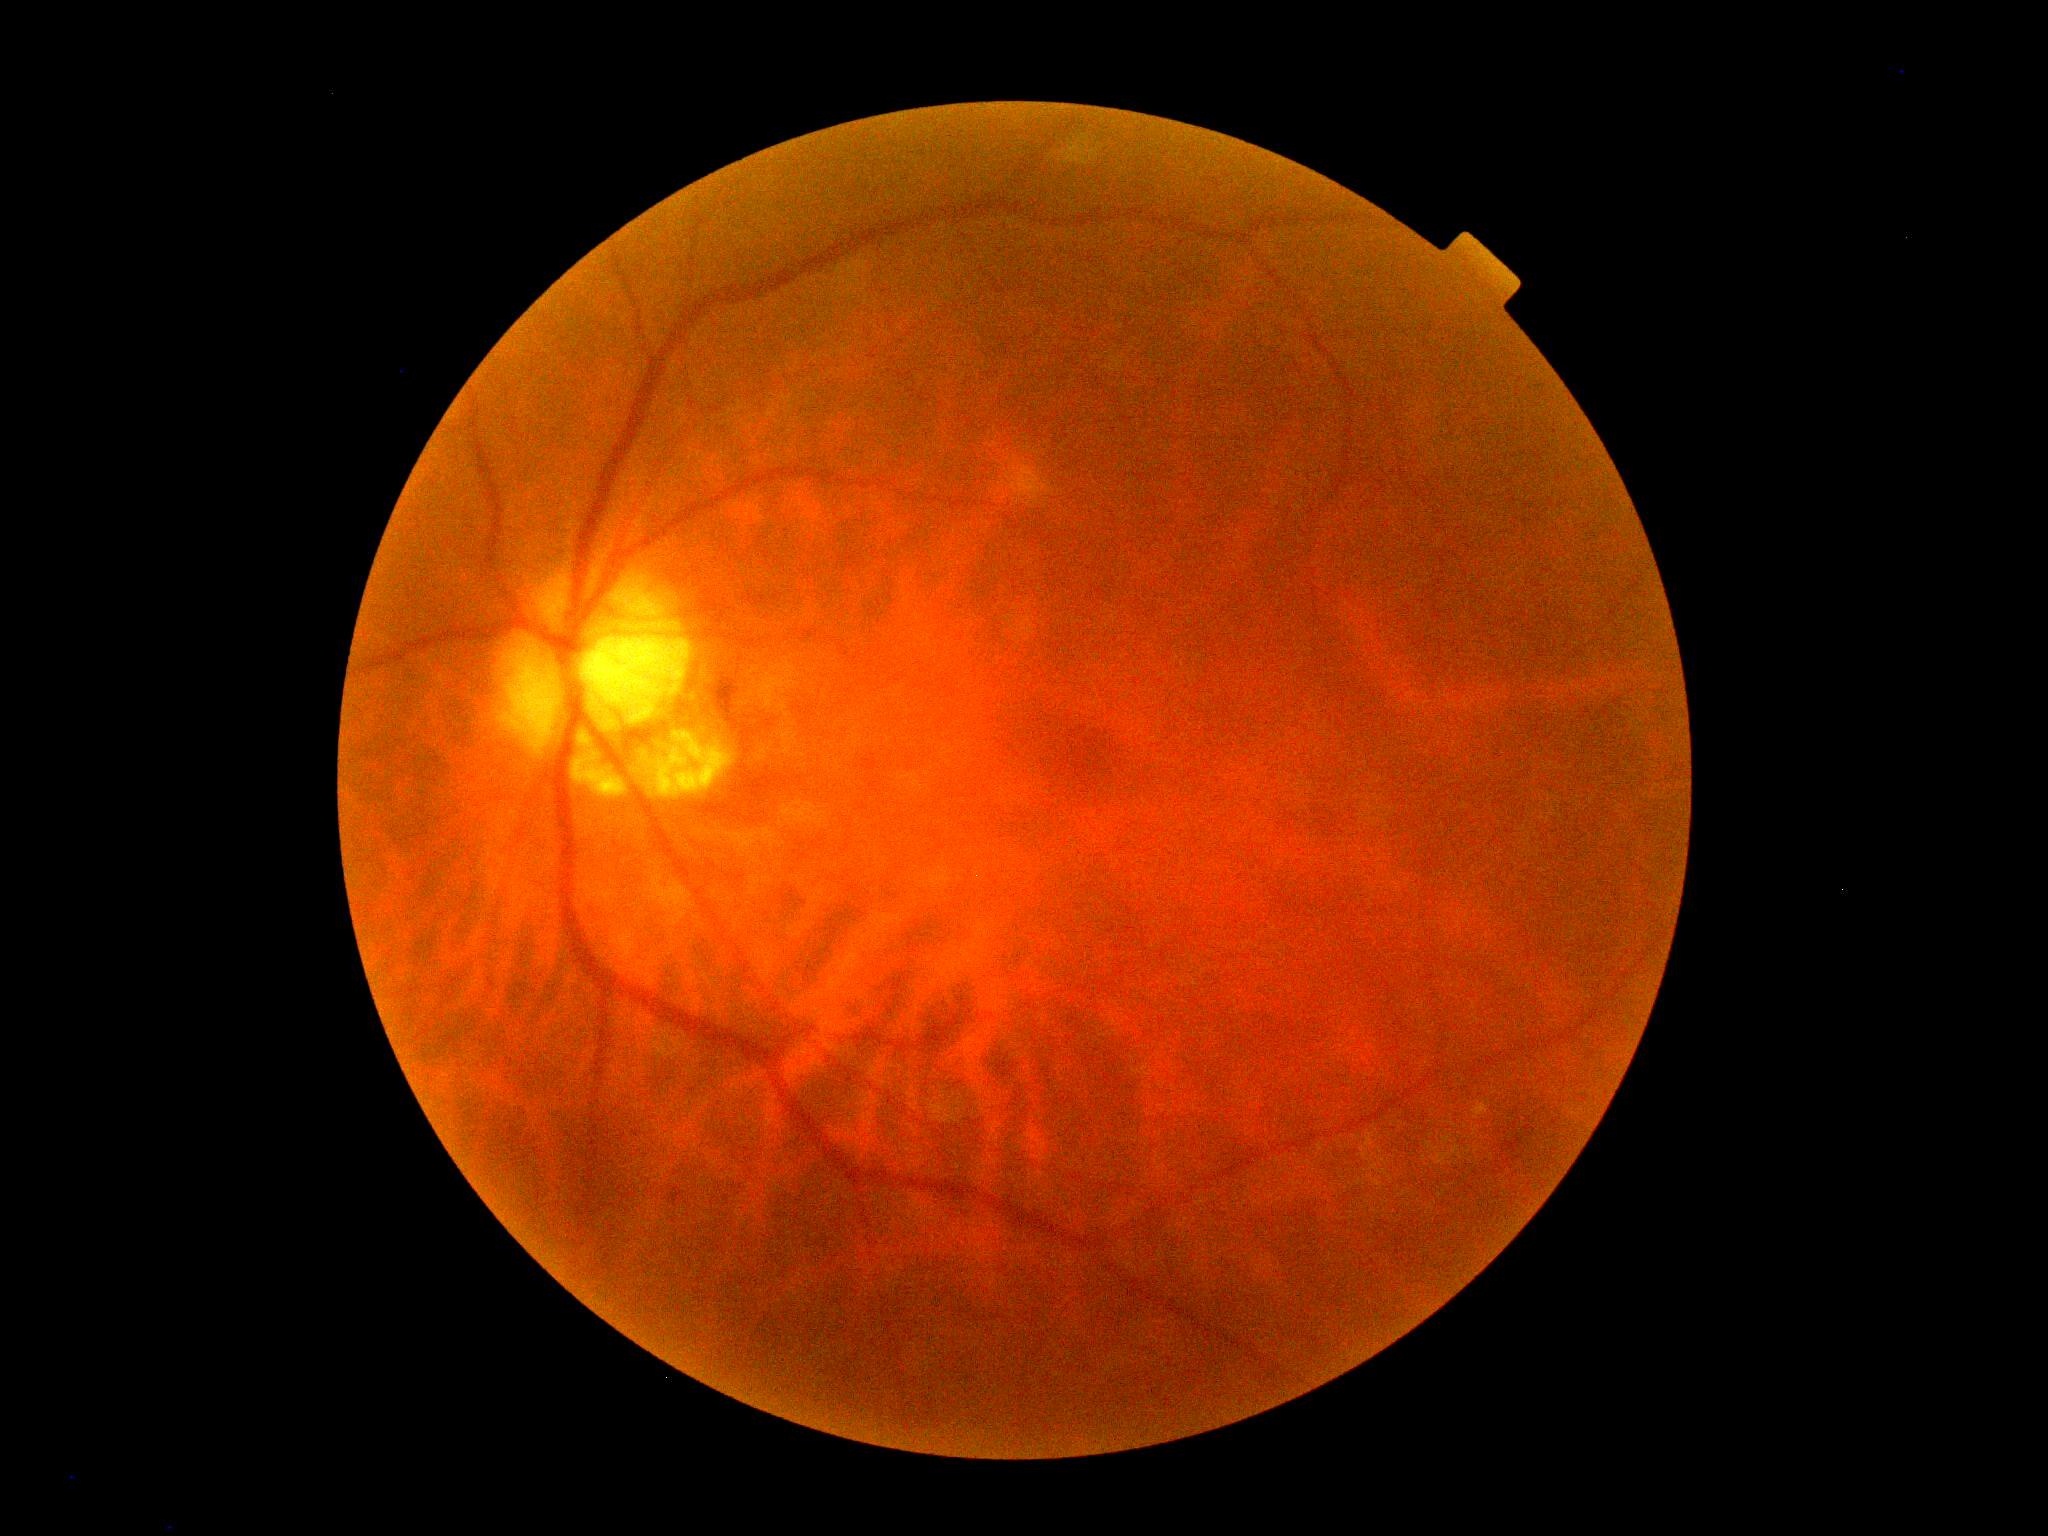
  dr_grade: moderate non-proliferative diabetic retinopathy (grade 2) — more than just microaneurysms but less than severe NPDR